Captured with the Natus RetCam Envision (130° field of view); 1440 x 1080 pixels; wide-field contact fundus photograph of an infant:
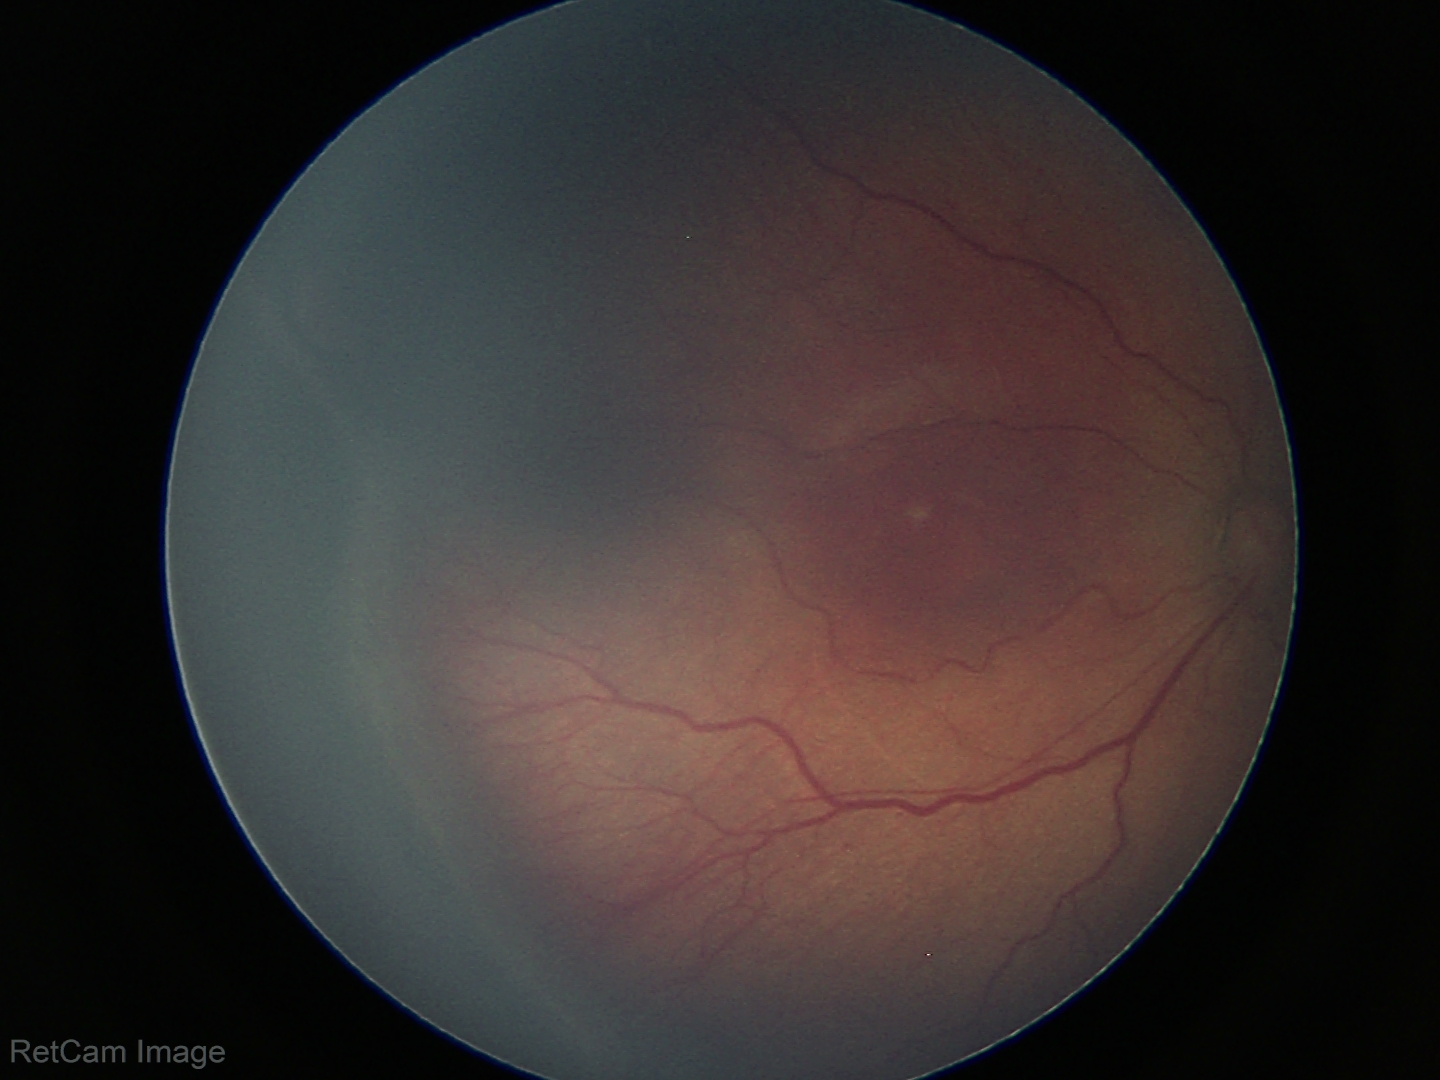 Diagnosis from this screening exam: ROP stage 3.
Without plus disease.